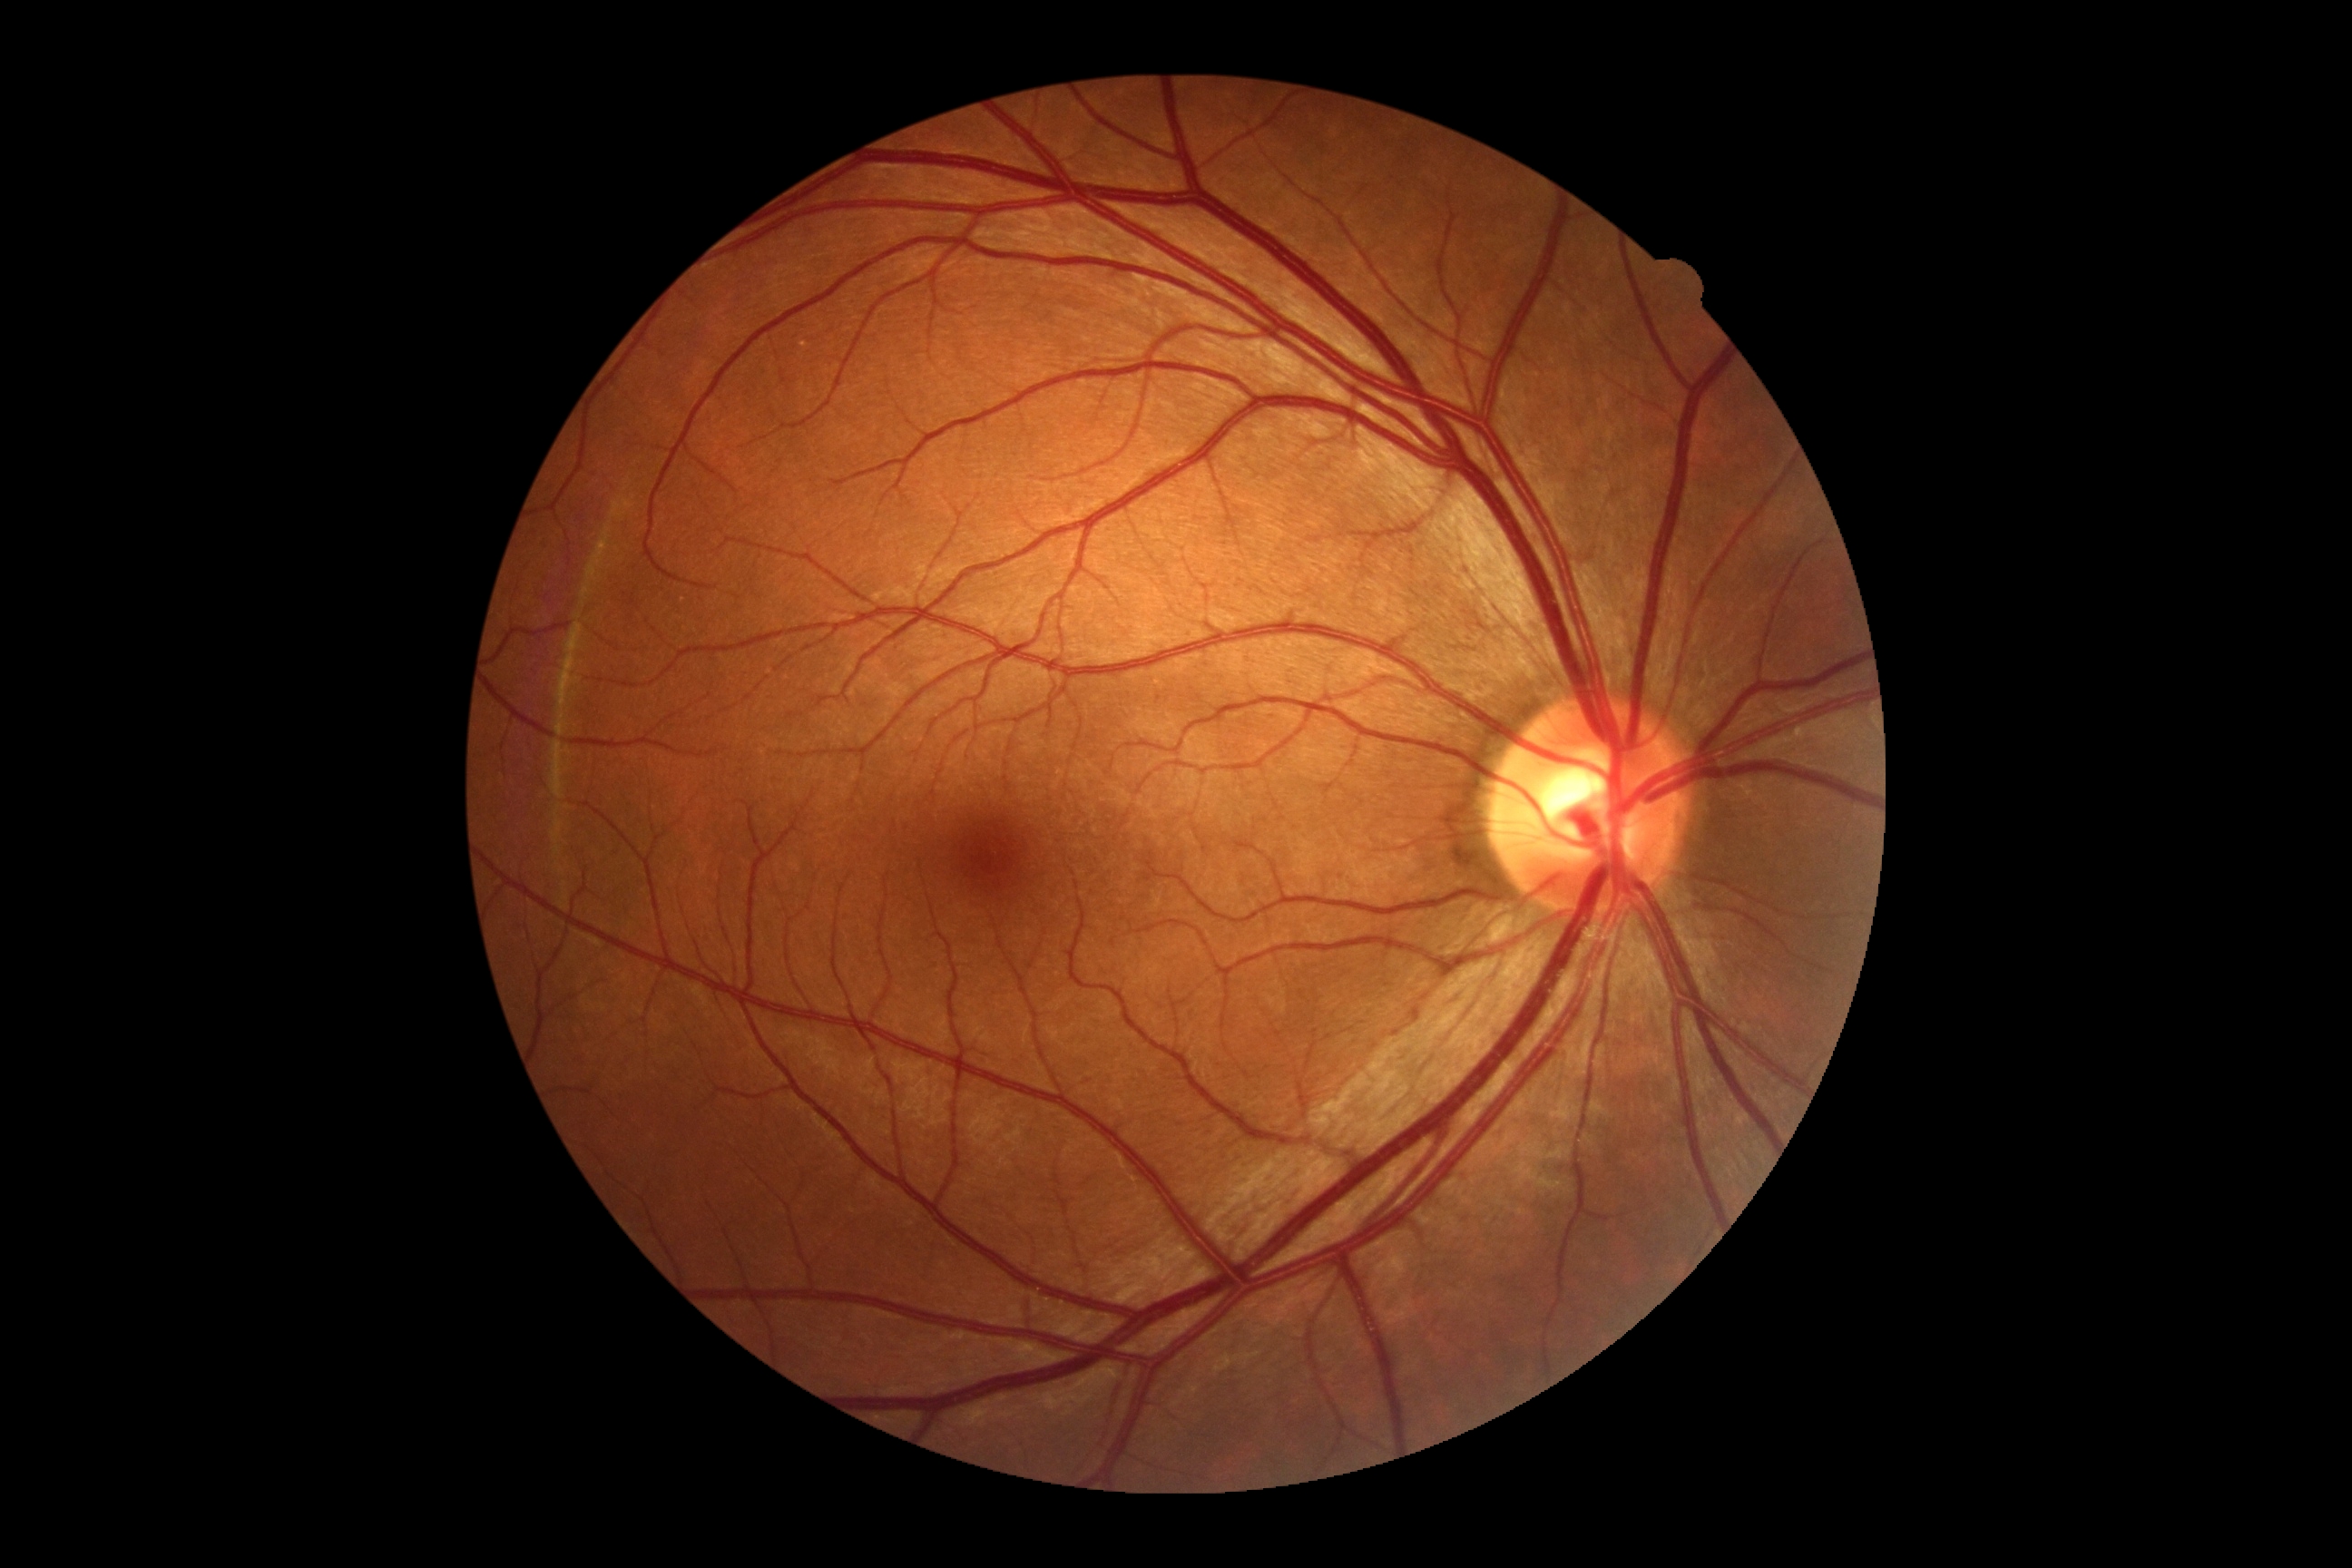 Diabetic retinopathy is 0/4.